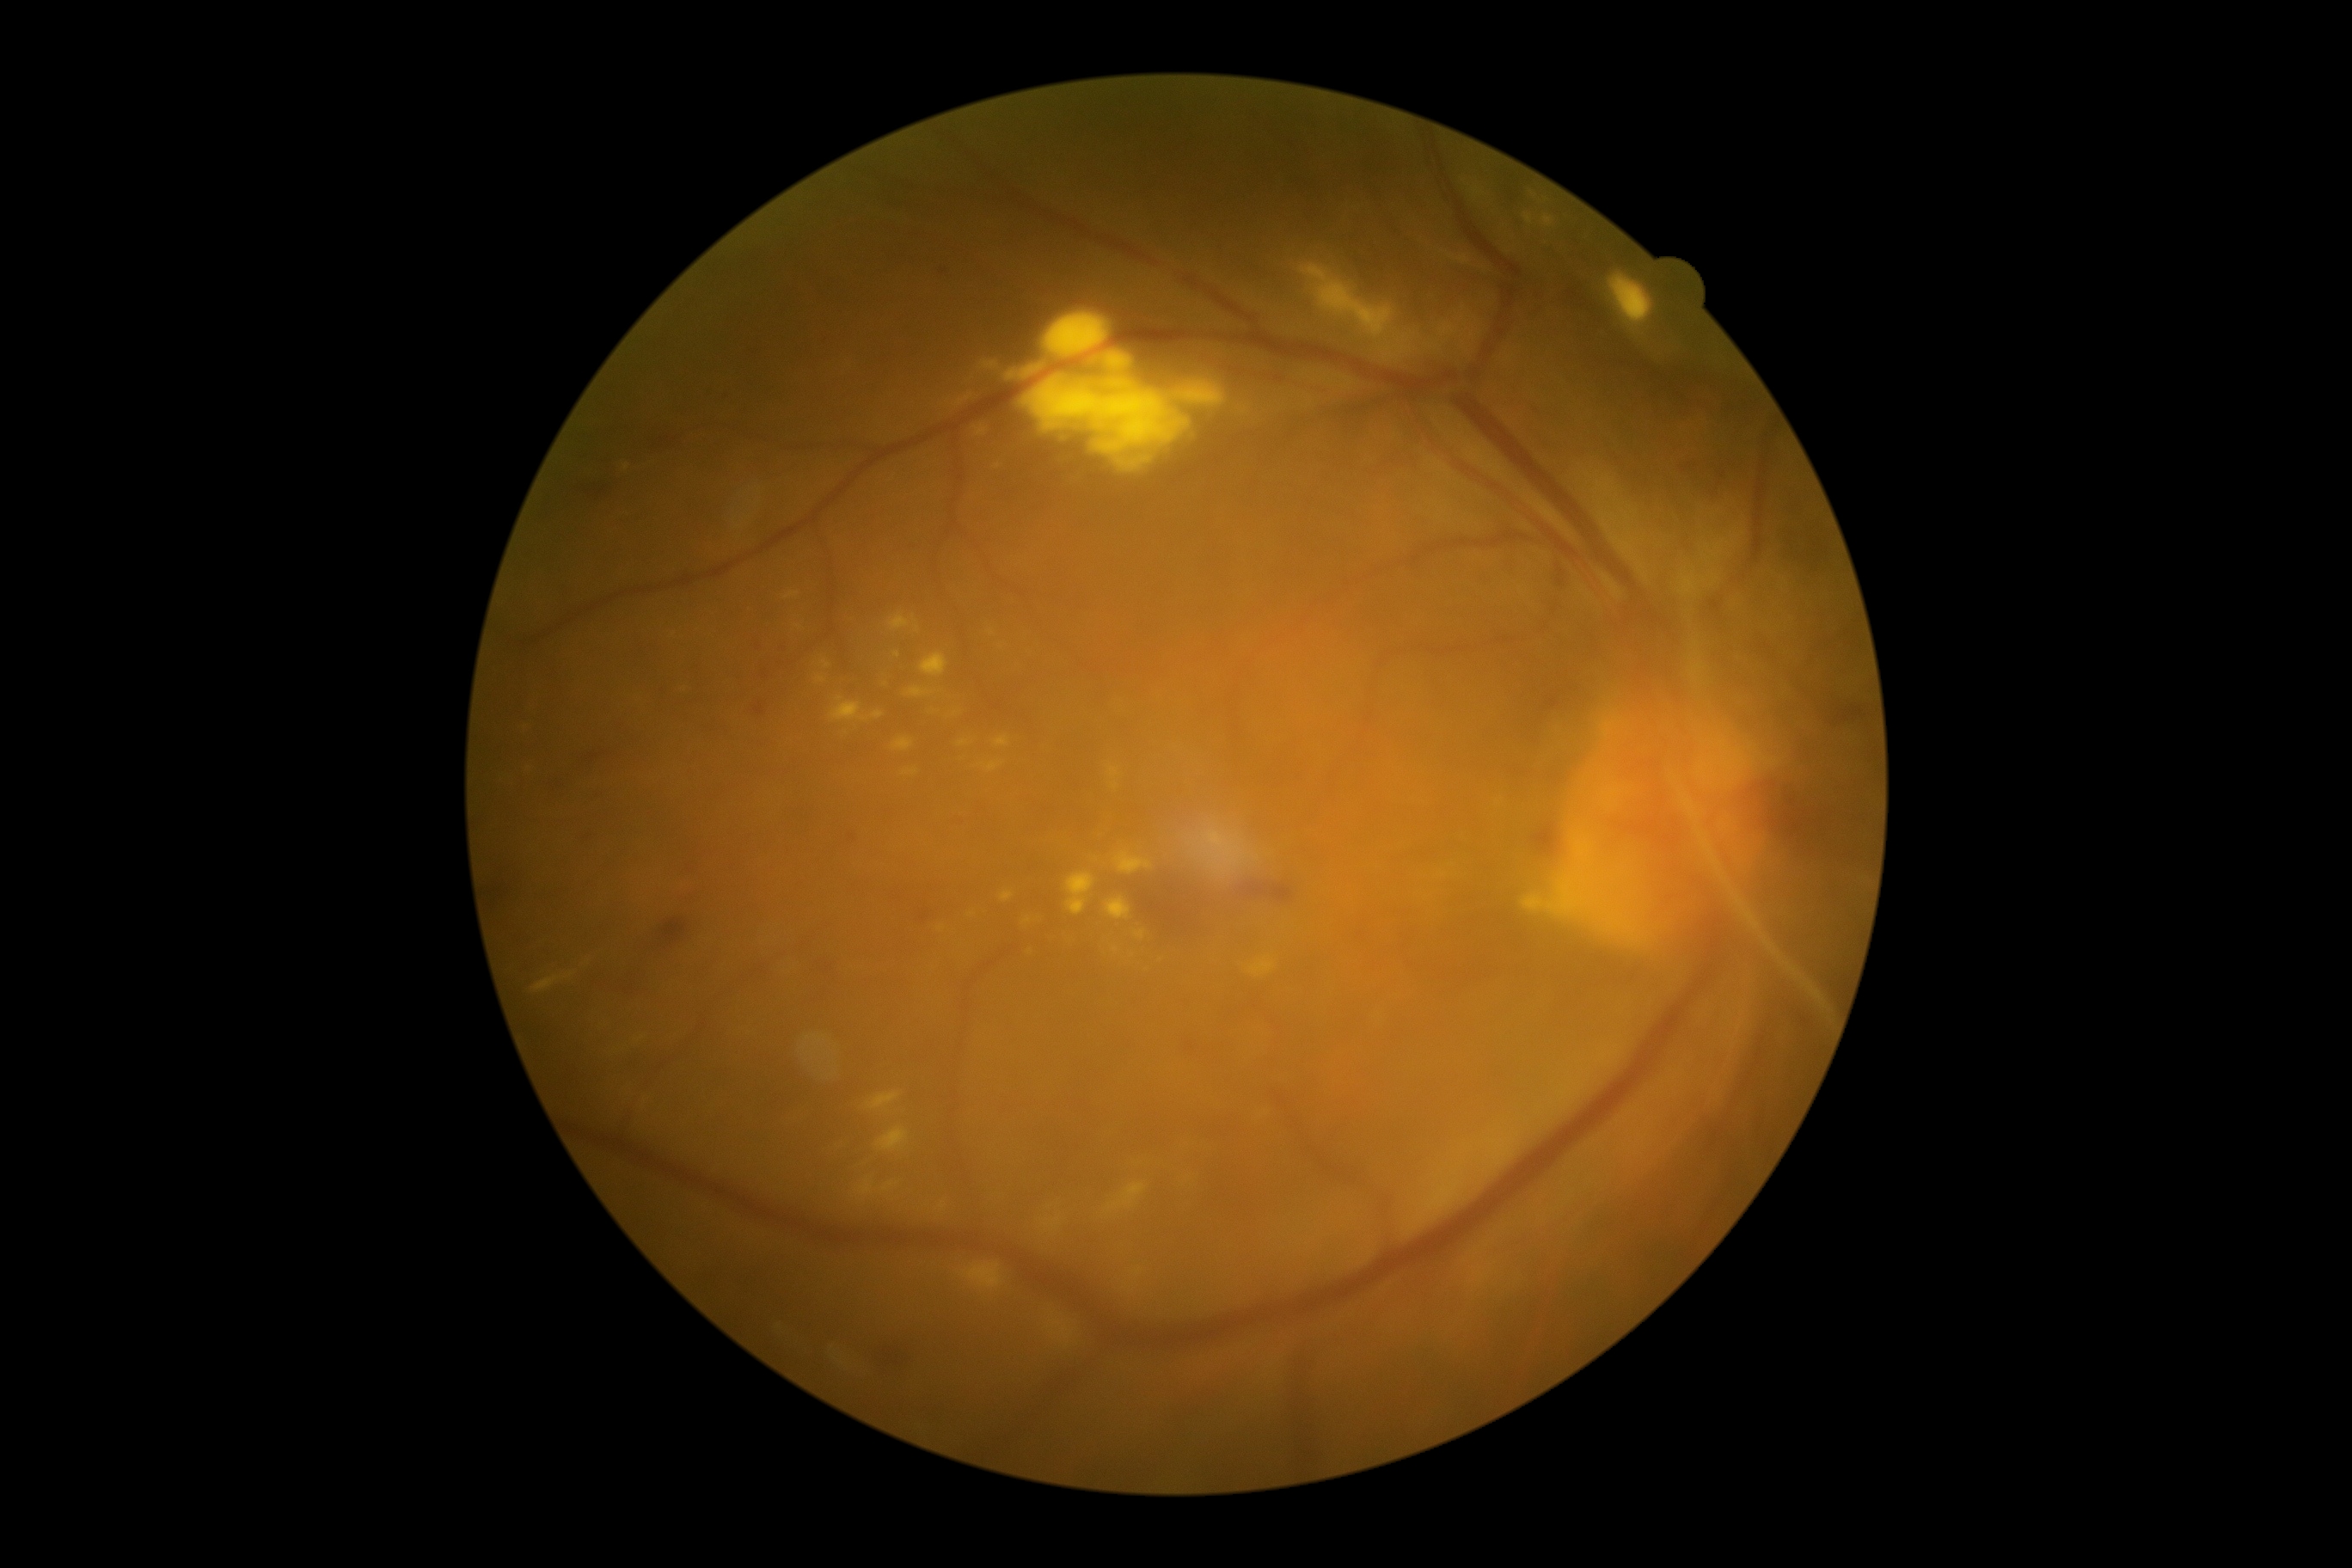 DR stage: grade 4 (PDR) — neovascularization and/or vitreous/pre-retinal hemorrhage
Lesions identified (partial list):
* MAs: (left=754, top=639, right=763, bottom=649); (left=754, top=702, right=766, bottom=716); (left=950, top=818, right=962, bottom=826); (left=757, top=670, right=768, bottom=677)
* Smaller MAs around 944, 272; 707, 391; 851, 837; 727, 398; 923, 919; 786, 647
* HEs (continued): (left=623, top=977, right=644, bottom=993); (left=661, top=919, right=687, bottom=943); (left=587, top=486, right=616, bottom=499); (left=489, top=888, right=506, bottom=907); (left=582, top=835, right=596, bottom=847); (left=1677, top=467, right=1698, bottom=474); (left=584, top=750, right=608, bottom=769); (left=823, top=962, right=842, bottom=971); (left=1533, top=824, right=1559, bottom=855); (left=873, top=1352, right=907, bottom=1375); (left=1247, top=885, right=1294, bottom=903); (left=654, top=432, right=683, bottom=450); (left=549, top=783, right=565, bottom=793)
* SEs: none
* EXs (continued): (left=873, top=711, right=885, bottom=720); (left=995, top=737, right=1010, bottom=747); (left=1524, top=214, right=1533, bottom=224); (left=1106, top=898, right=1132, bottom=921); (left=1048, top=1320, right=1075, bottom=1347); (left=857, top=1179, right=874, bottom=1197); (left=979, top=360, right=998, bottom=371); (left=1175, top=383, right=1227, bottom=408); (left=1043, top=1218, right=1062, bottom=1232); (left=821, top=661, right=831, bottom=670); (left=830, top=697, right=869, bottom=723); (left=1185, top=1175, right=1196, bottom=1182); (left=1024, top=376, right=1189, bottom=456); (left=1134, top=931, right=1146, bottom=941)
* Smaller EXs around 1049, 1208; 997, 467; 1123, 464; 941, 929; 991, 632